2212 by 1659 pixels · retinal fundus photograph · 45-degree field of view: 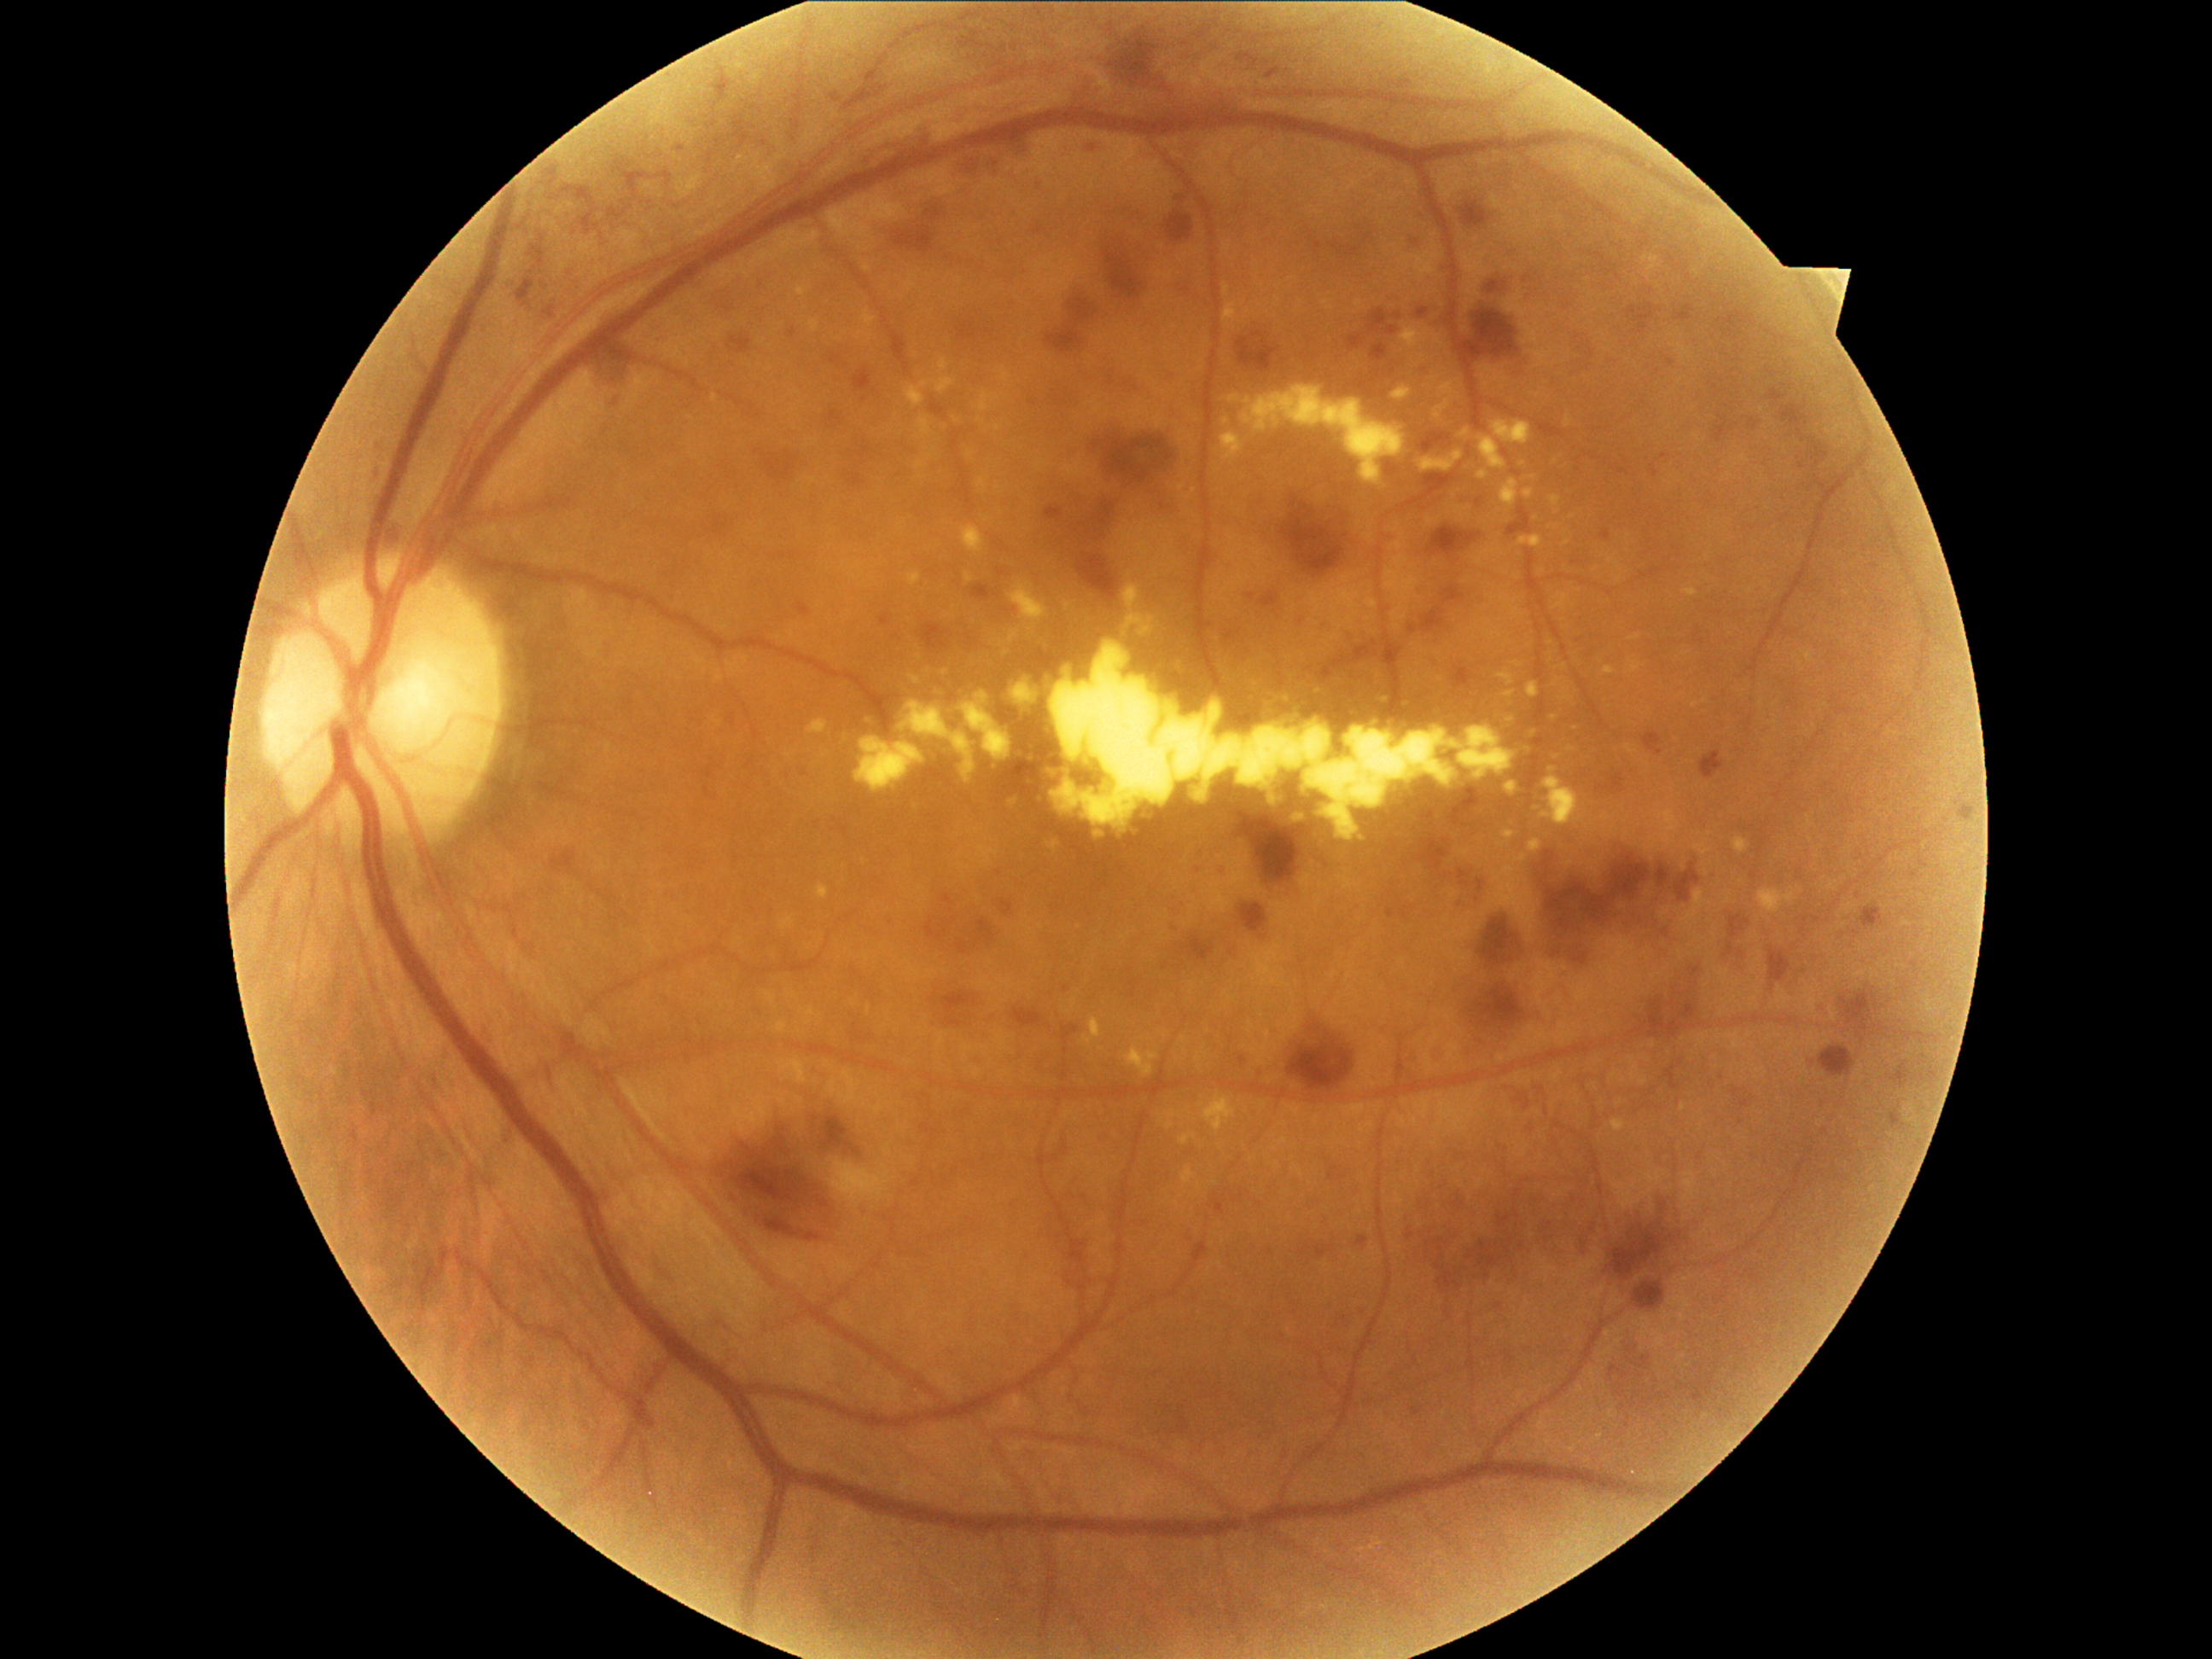 <lesions partial="true">
  <dr_grade>3</dr_grade>
  <he partial="true">box=[1417, 308, 1431, 320]; box=[1064, 986, 1069, 994]; box=[1329, 1167, 1346, 1182]; box=[1626, 305, 1656, 335]; box=[1368, 310, 1399, 337]; box=[1962, 810, 1976, 818]; box=[892, 226, 934, 253]; box=[1288, 1022, 1358, 1105]; box=[827, 352, 849, 370]; box=[1767, 385, 1813, 433]; box=[1300, 1242, 1336, 1262]; box=[728, 334, 752, 354]; box=[593, 346, 639, 381]; box=[1262, 593, 1281, 610]; box=[1839, 986, 1890, 1047]; box=[1356, 1235, 1370, 1250]</he>
  <he_small_approx>[x=1791, y=385]</he_small_approx>
</lesions>